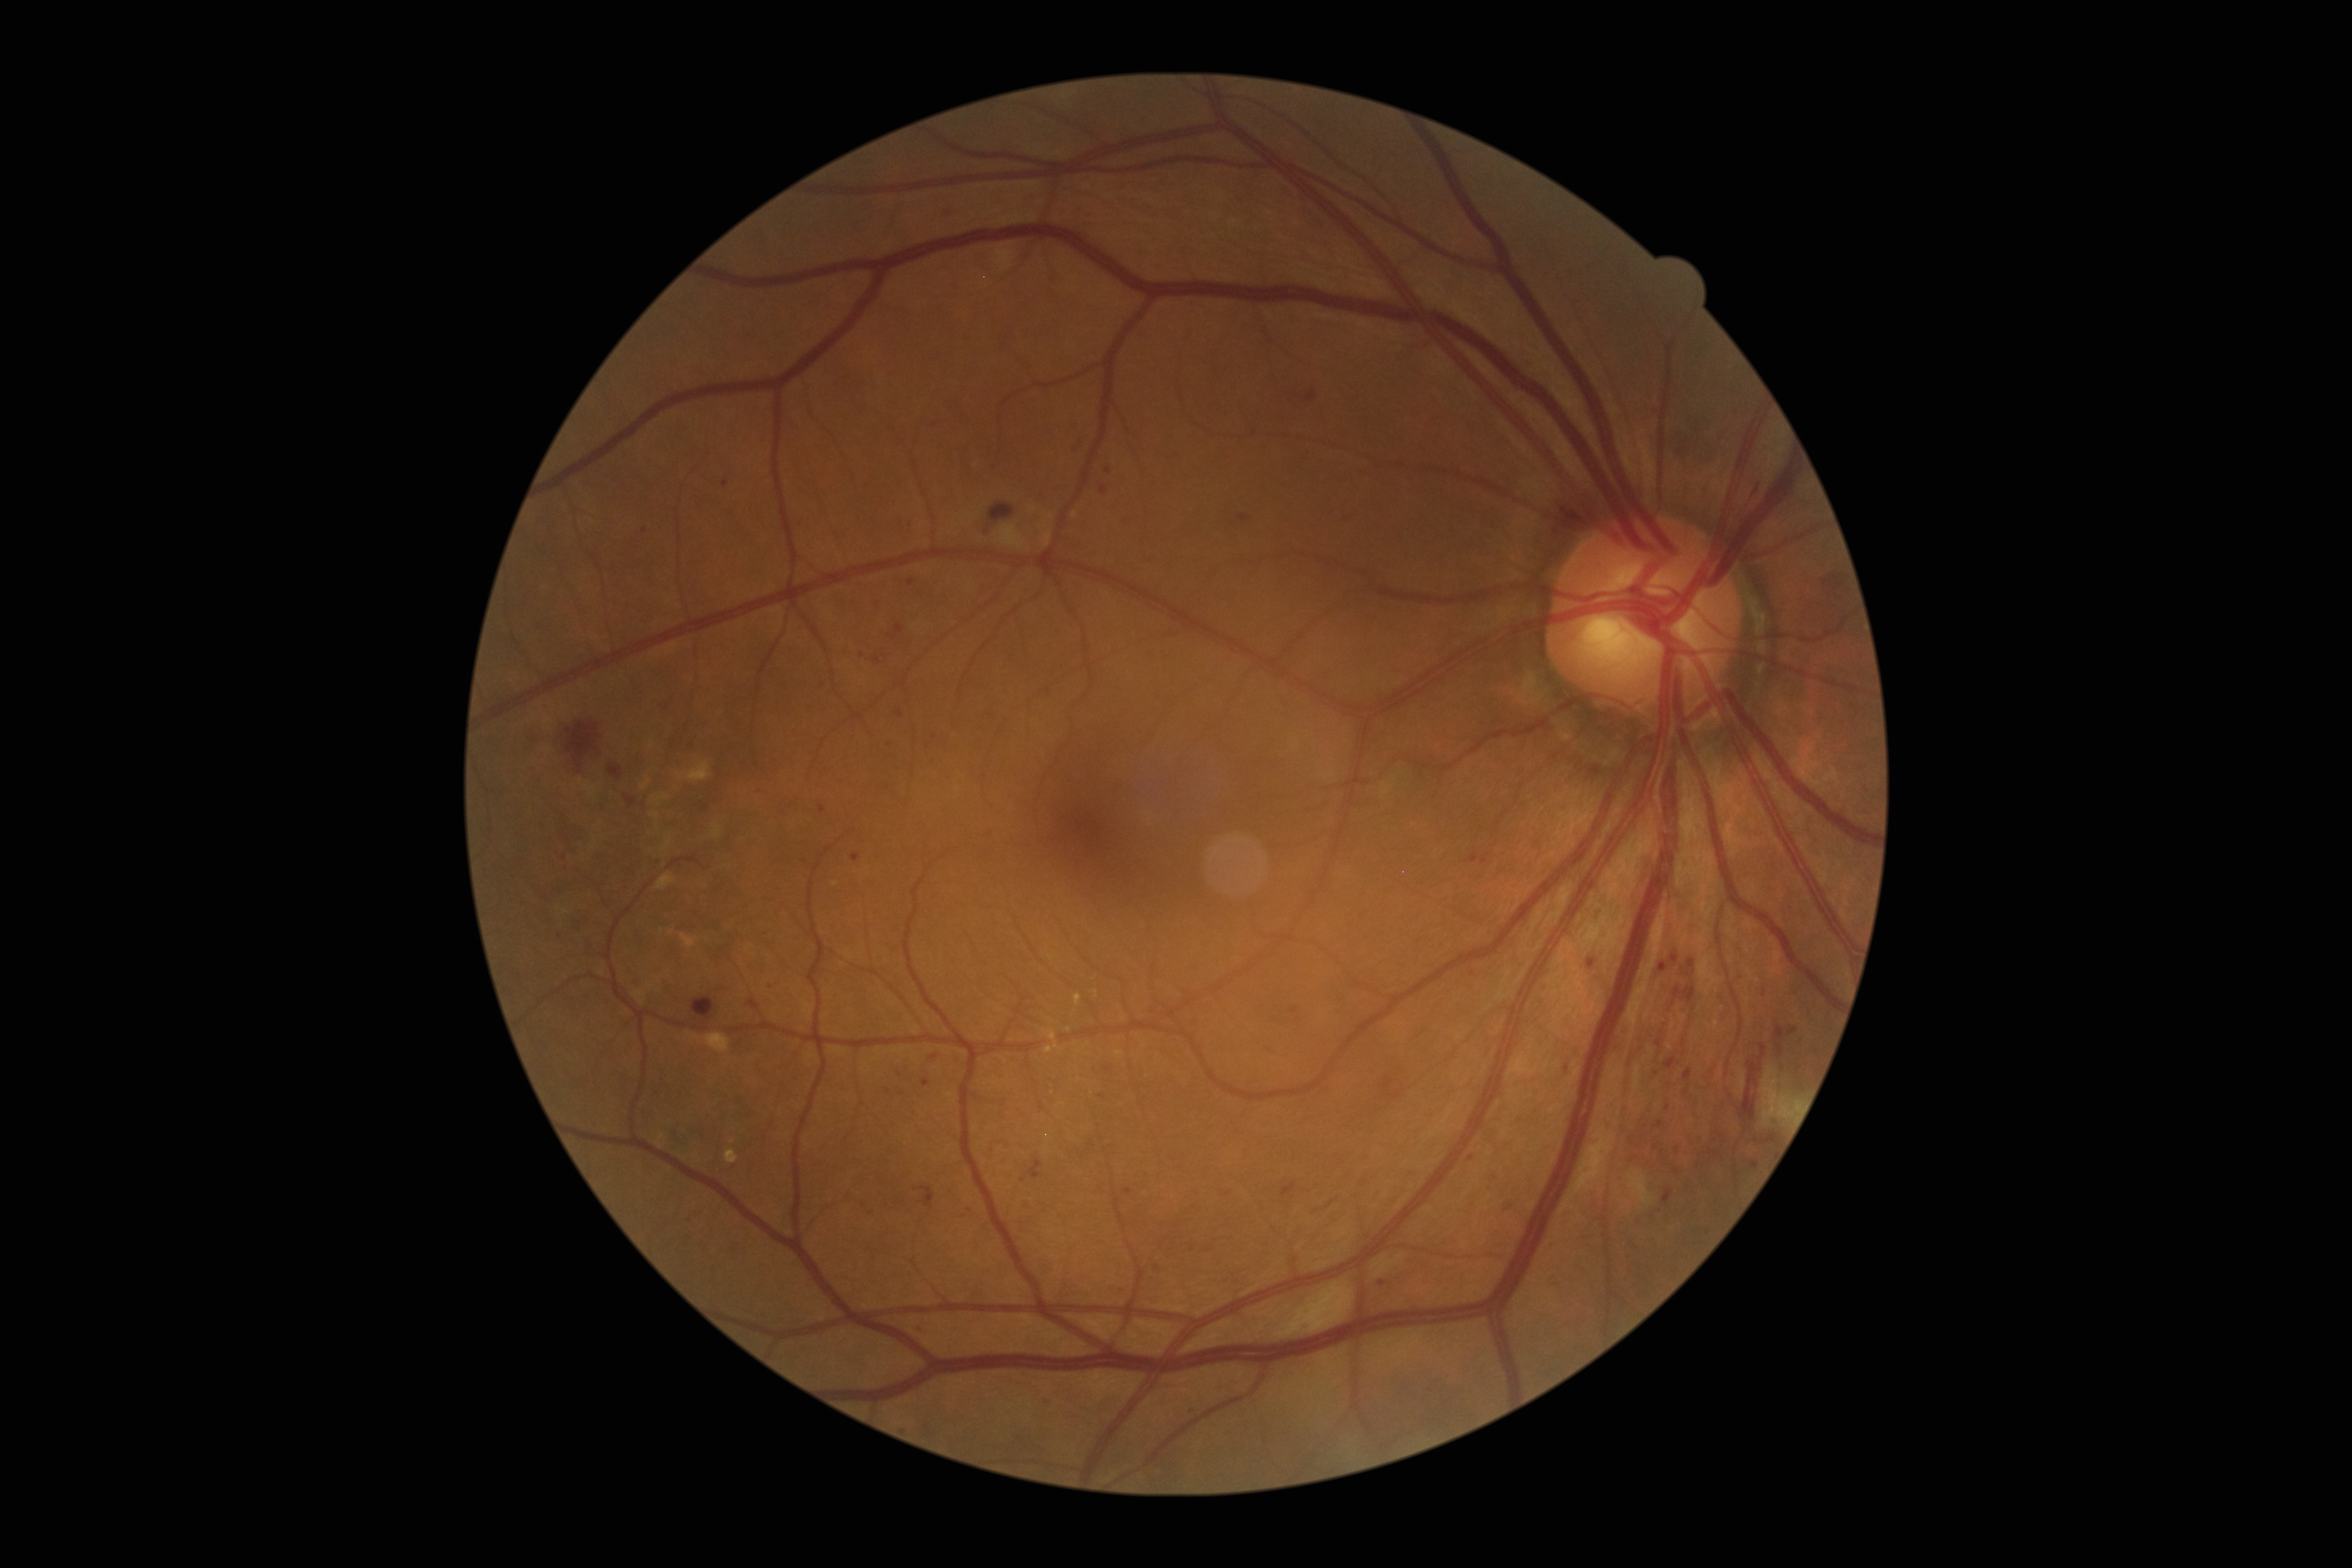

DR stage is moderate non-proliferative diabetic retinopathy (grade 2) — more than just microaneurysms but less than severe NPDR
A subset of detected lesions:
* MAs (more not shown): bbox=[1125, 1187, 1132, 1195]; bbox=[1829, 575, 1838, 583]; bbox=[1788, 1027, 1797, 1036]; bbox=[878, 601, 881, 610]; bbox=[1075, 439, 1087, 452]; bbox=[1238, 515, 1247, 523]; bbox=[923, 1080, 931, 1087]; bbox=[1662, 1190, 1673, 1203]; bbox=[748, 1000, 759, 1011]
* Smaller MAs around 823:685; 1656:1072; 1471:1158; 726:484; 1123:1294; 807:860; 1712:1152; 761:792; 1472:973